Fundus image cropped to the optic disc: 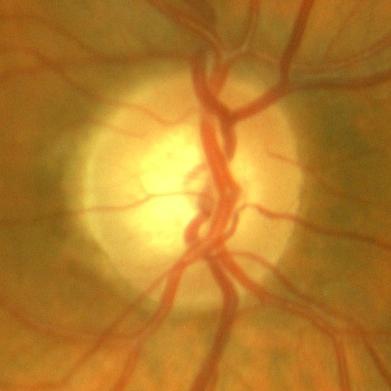

The image shows no glaucomatous findings.